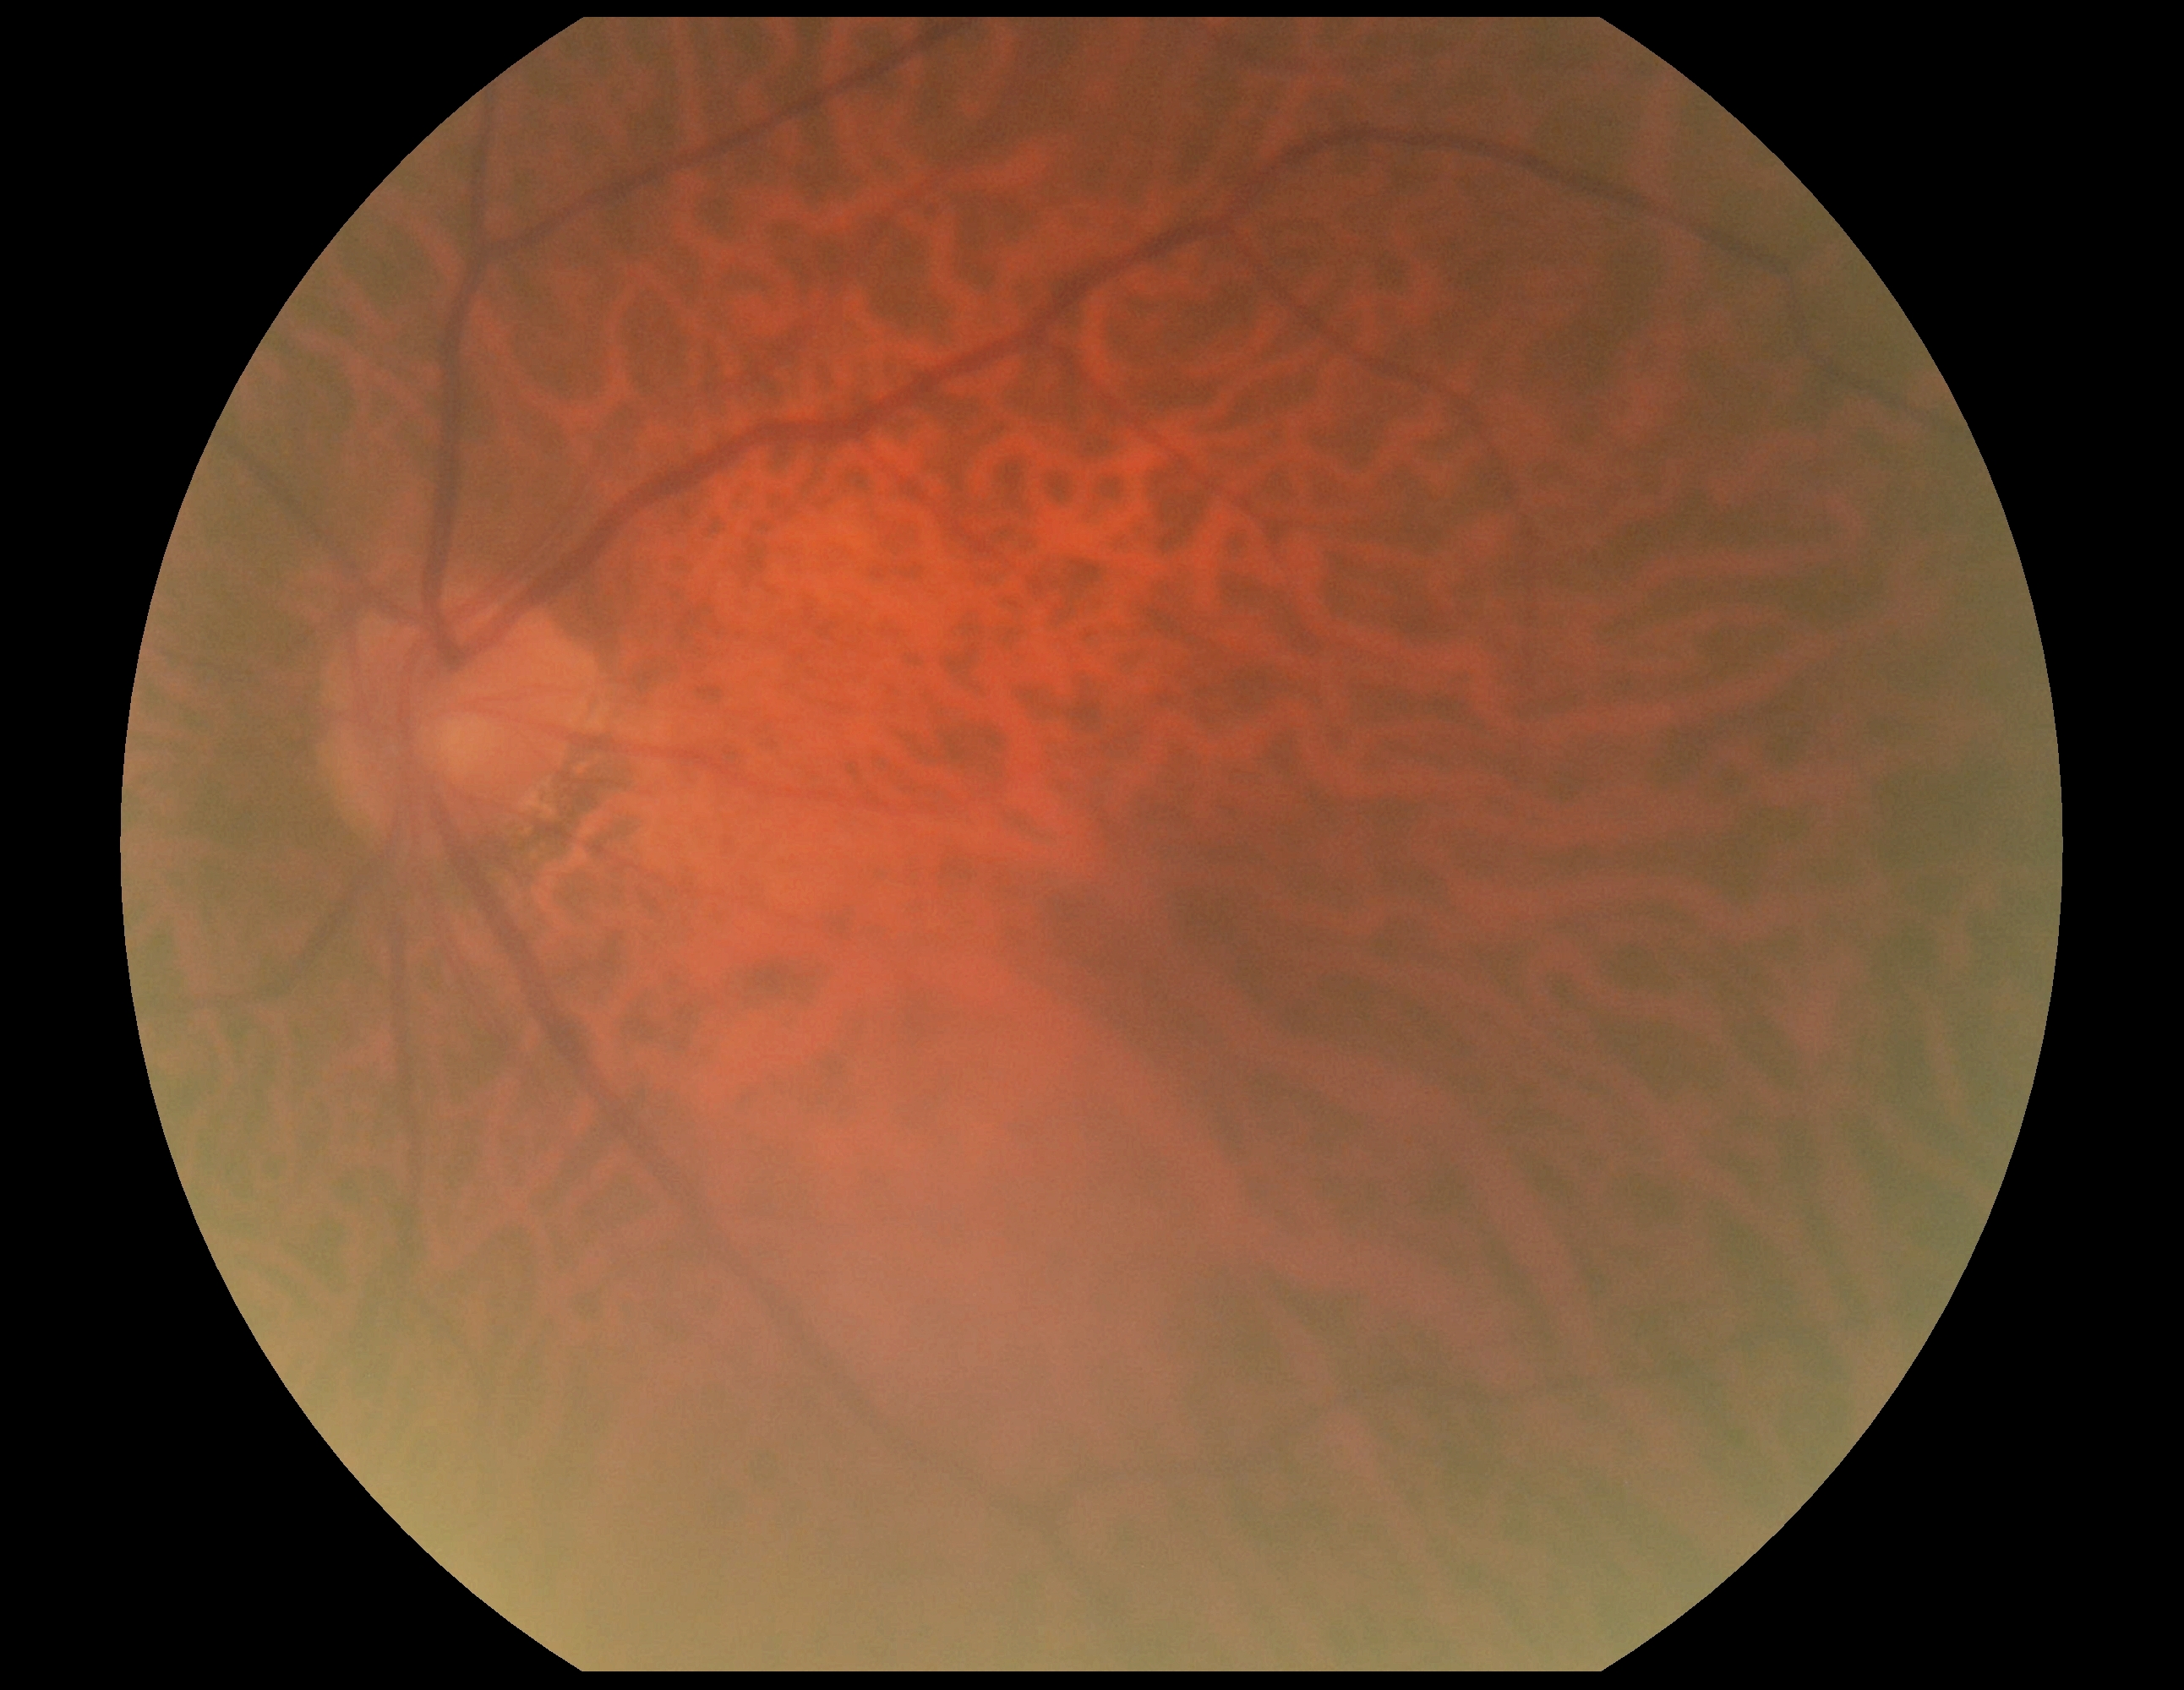 Diabetic retinopathy: no apparent retinopathy (grade 0). No diabetic retinal disease findings.